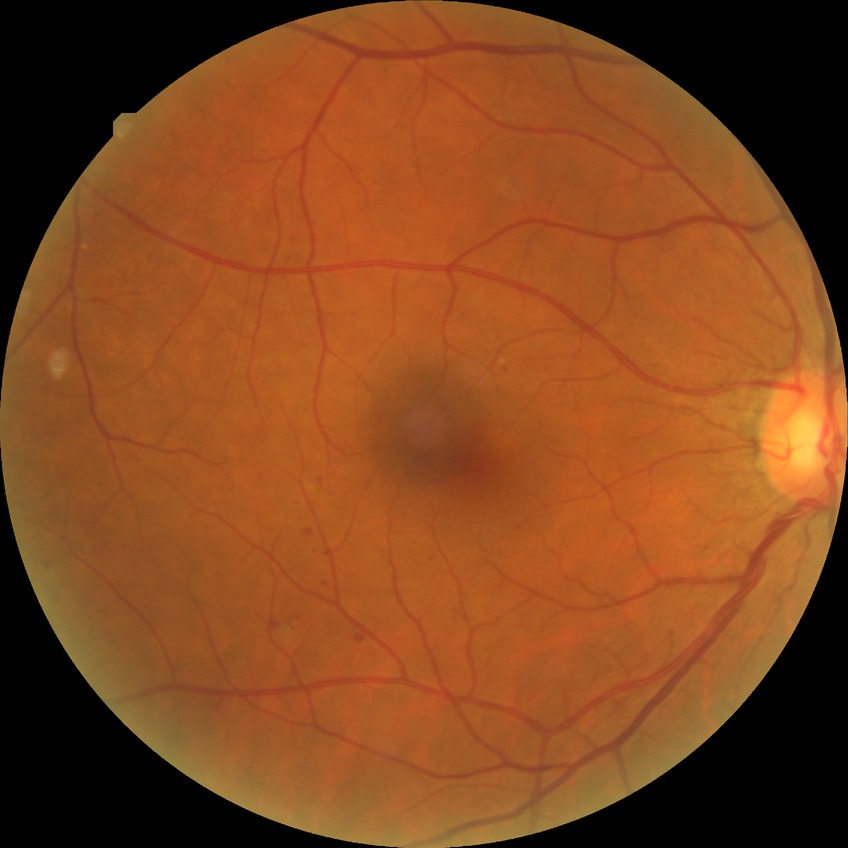 Modified Davis classification: simple diabetic retinopathy.